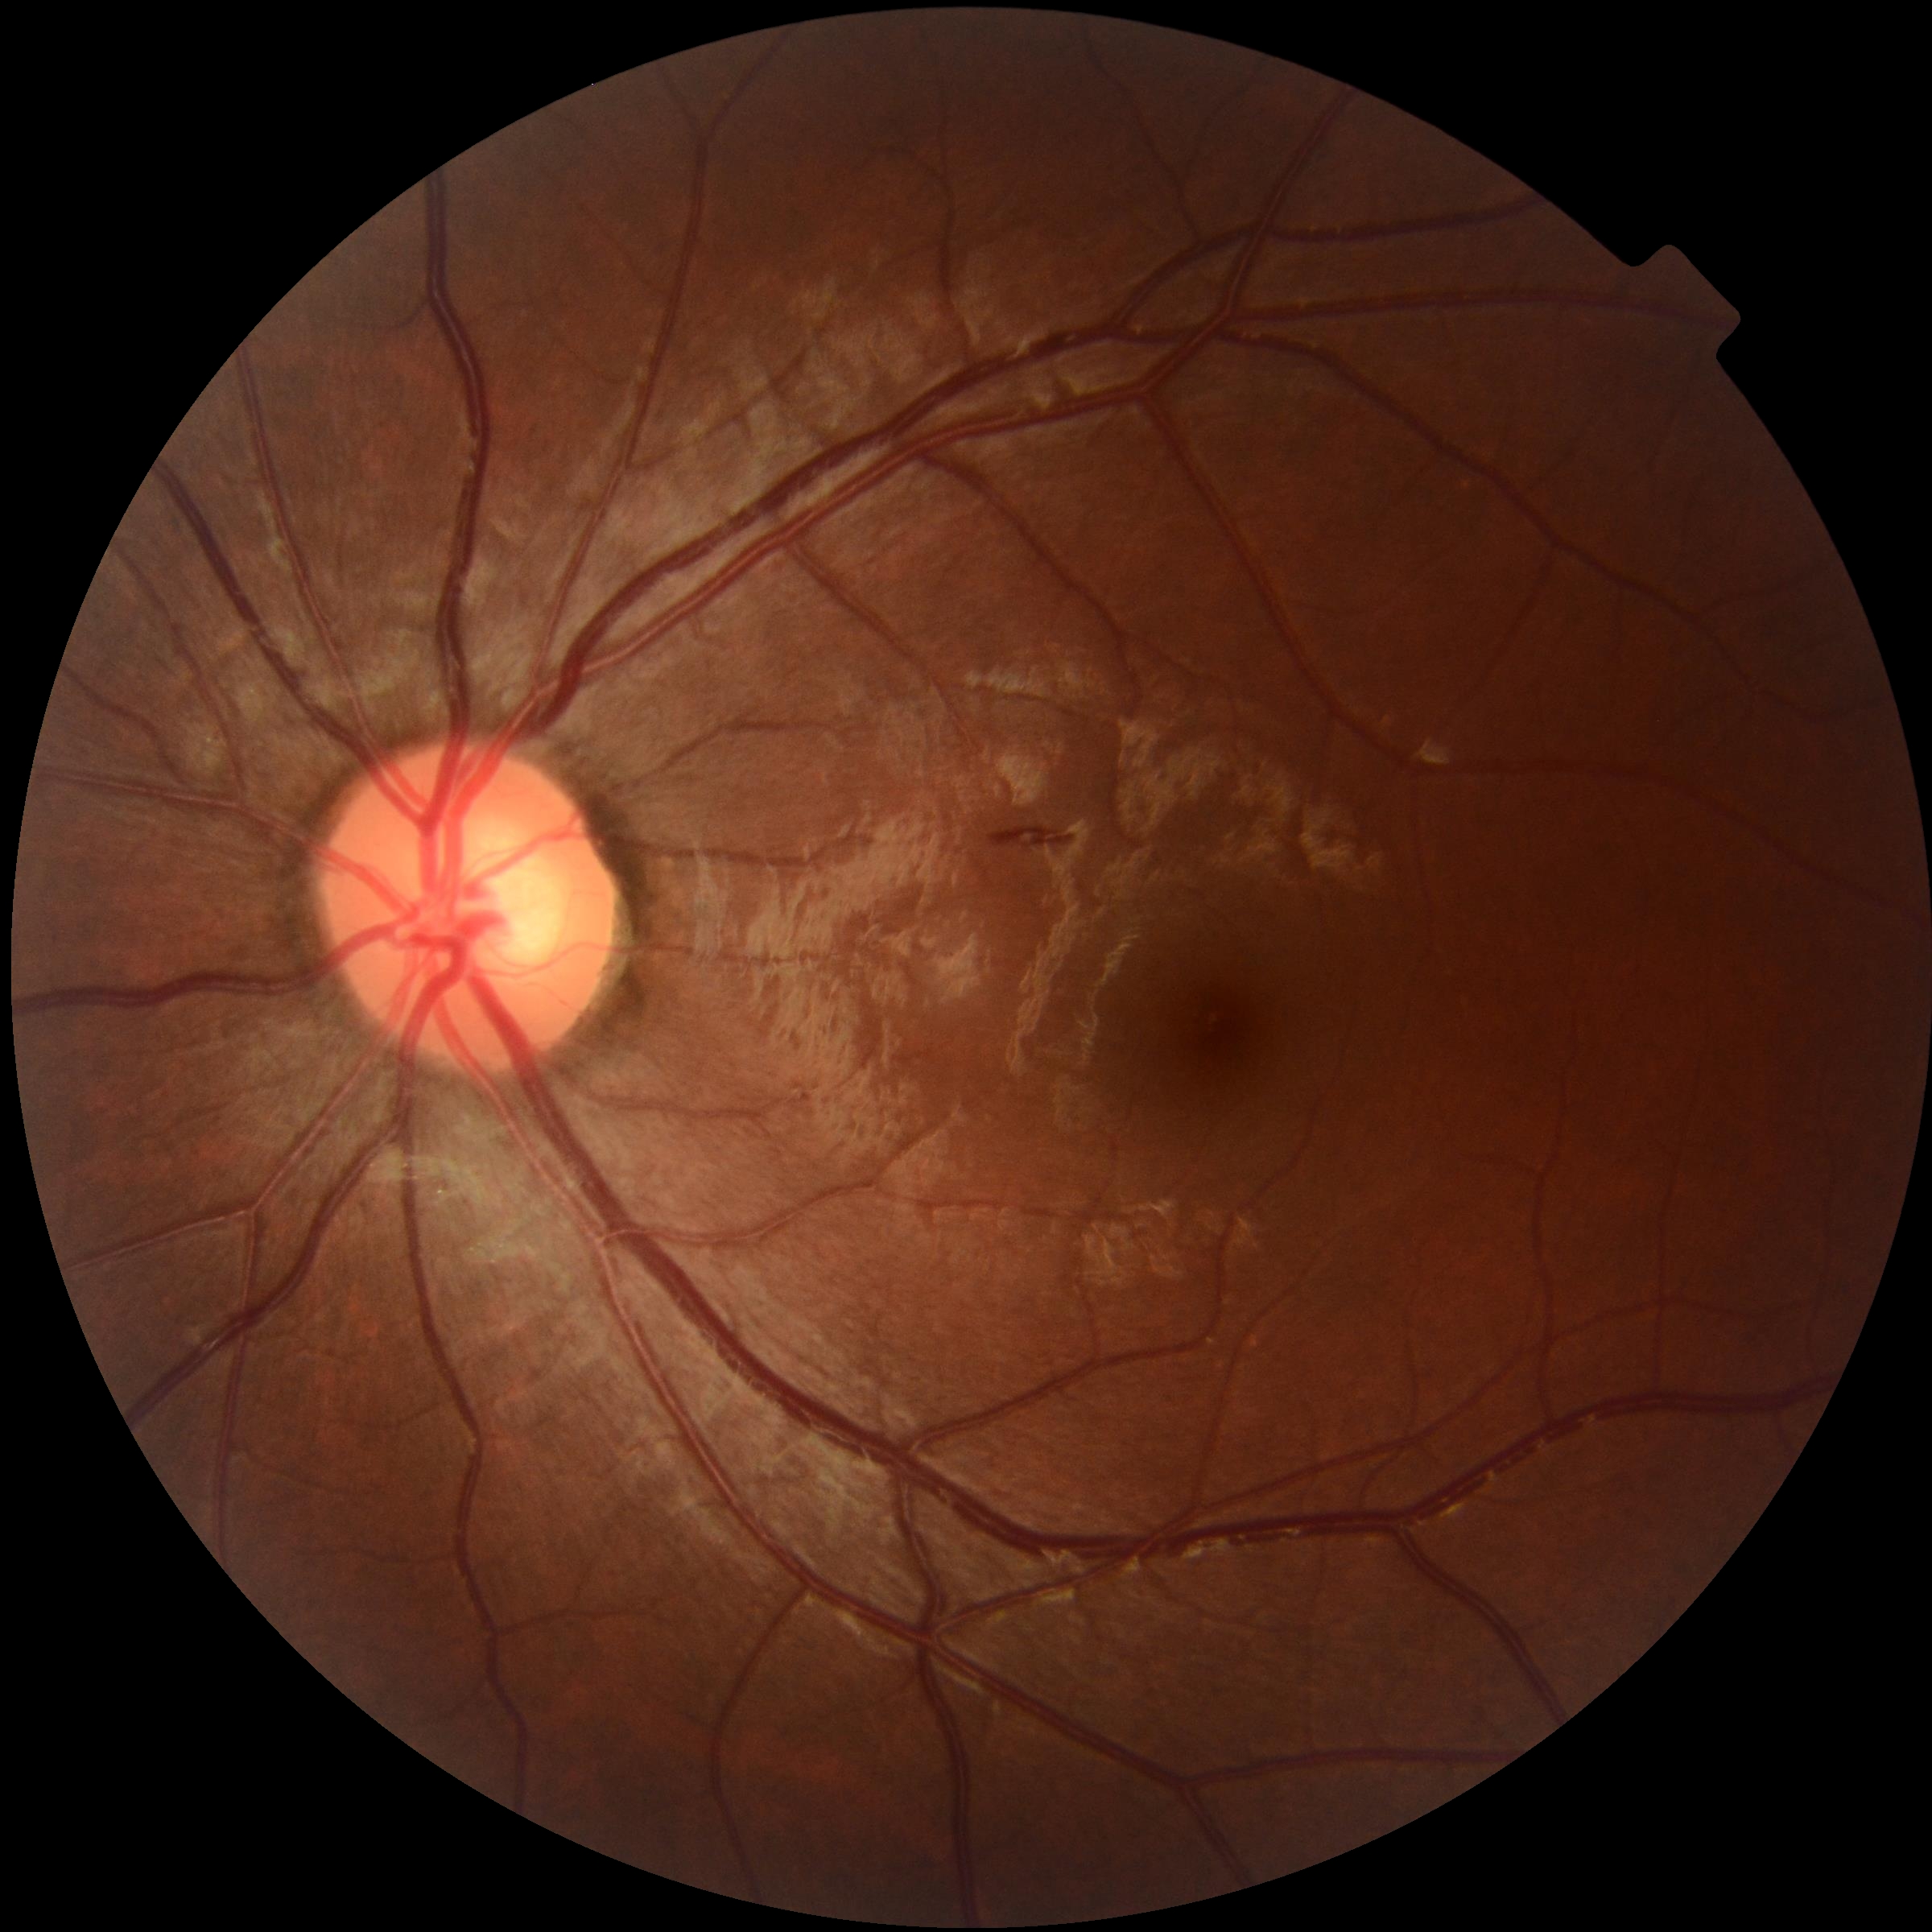
– DR class: non-proliferative diabetic retinopathy
– retinopathy grade: moderate NPDR (2)